Patient age: 50 years. Acquired with a Topcon TRC-NW400. Optic disc at the center of the field. Gender: F. Undilated pupil. IOP: 20 mmHg. 30° field of view.
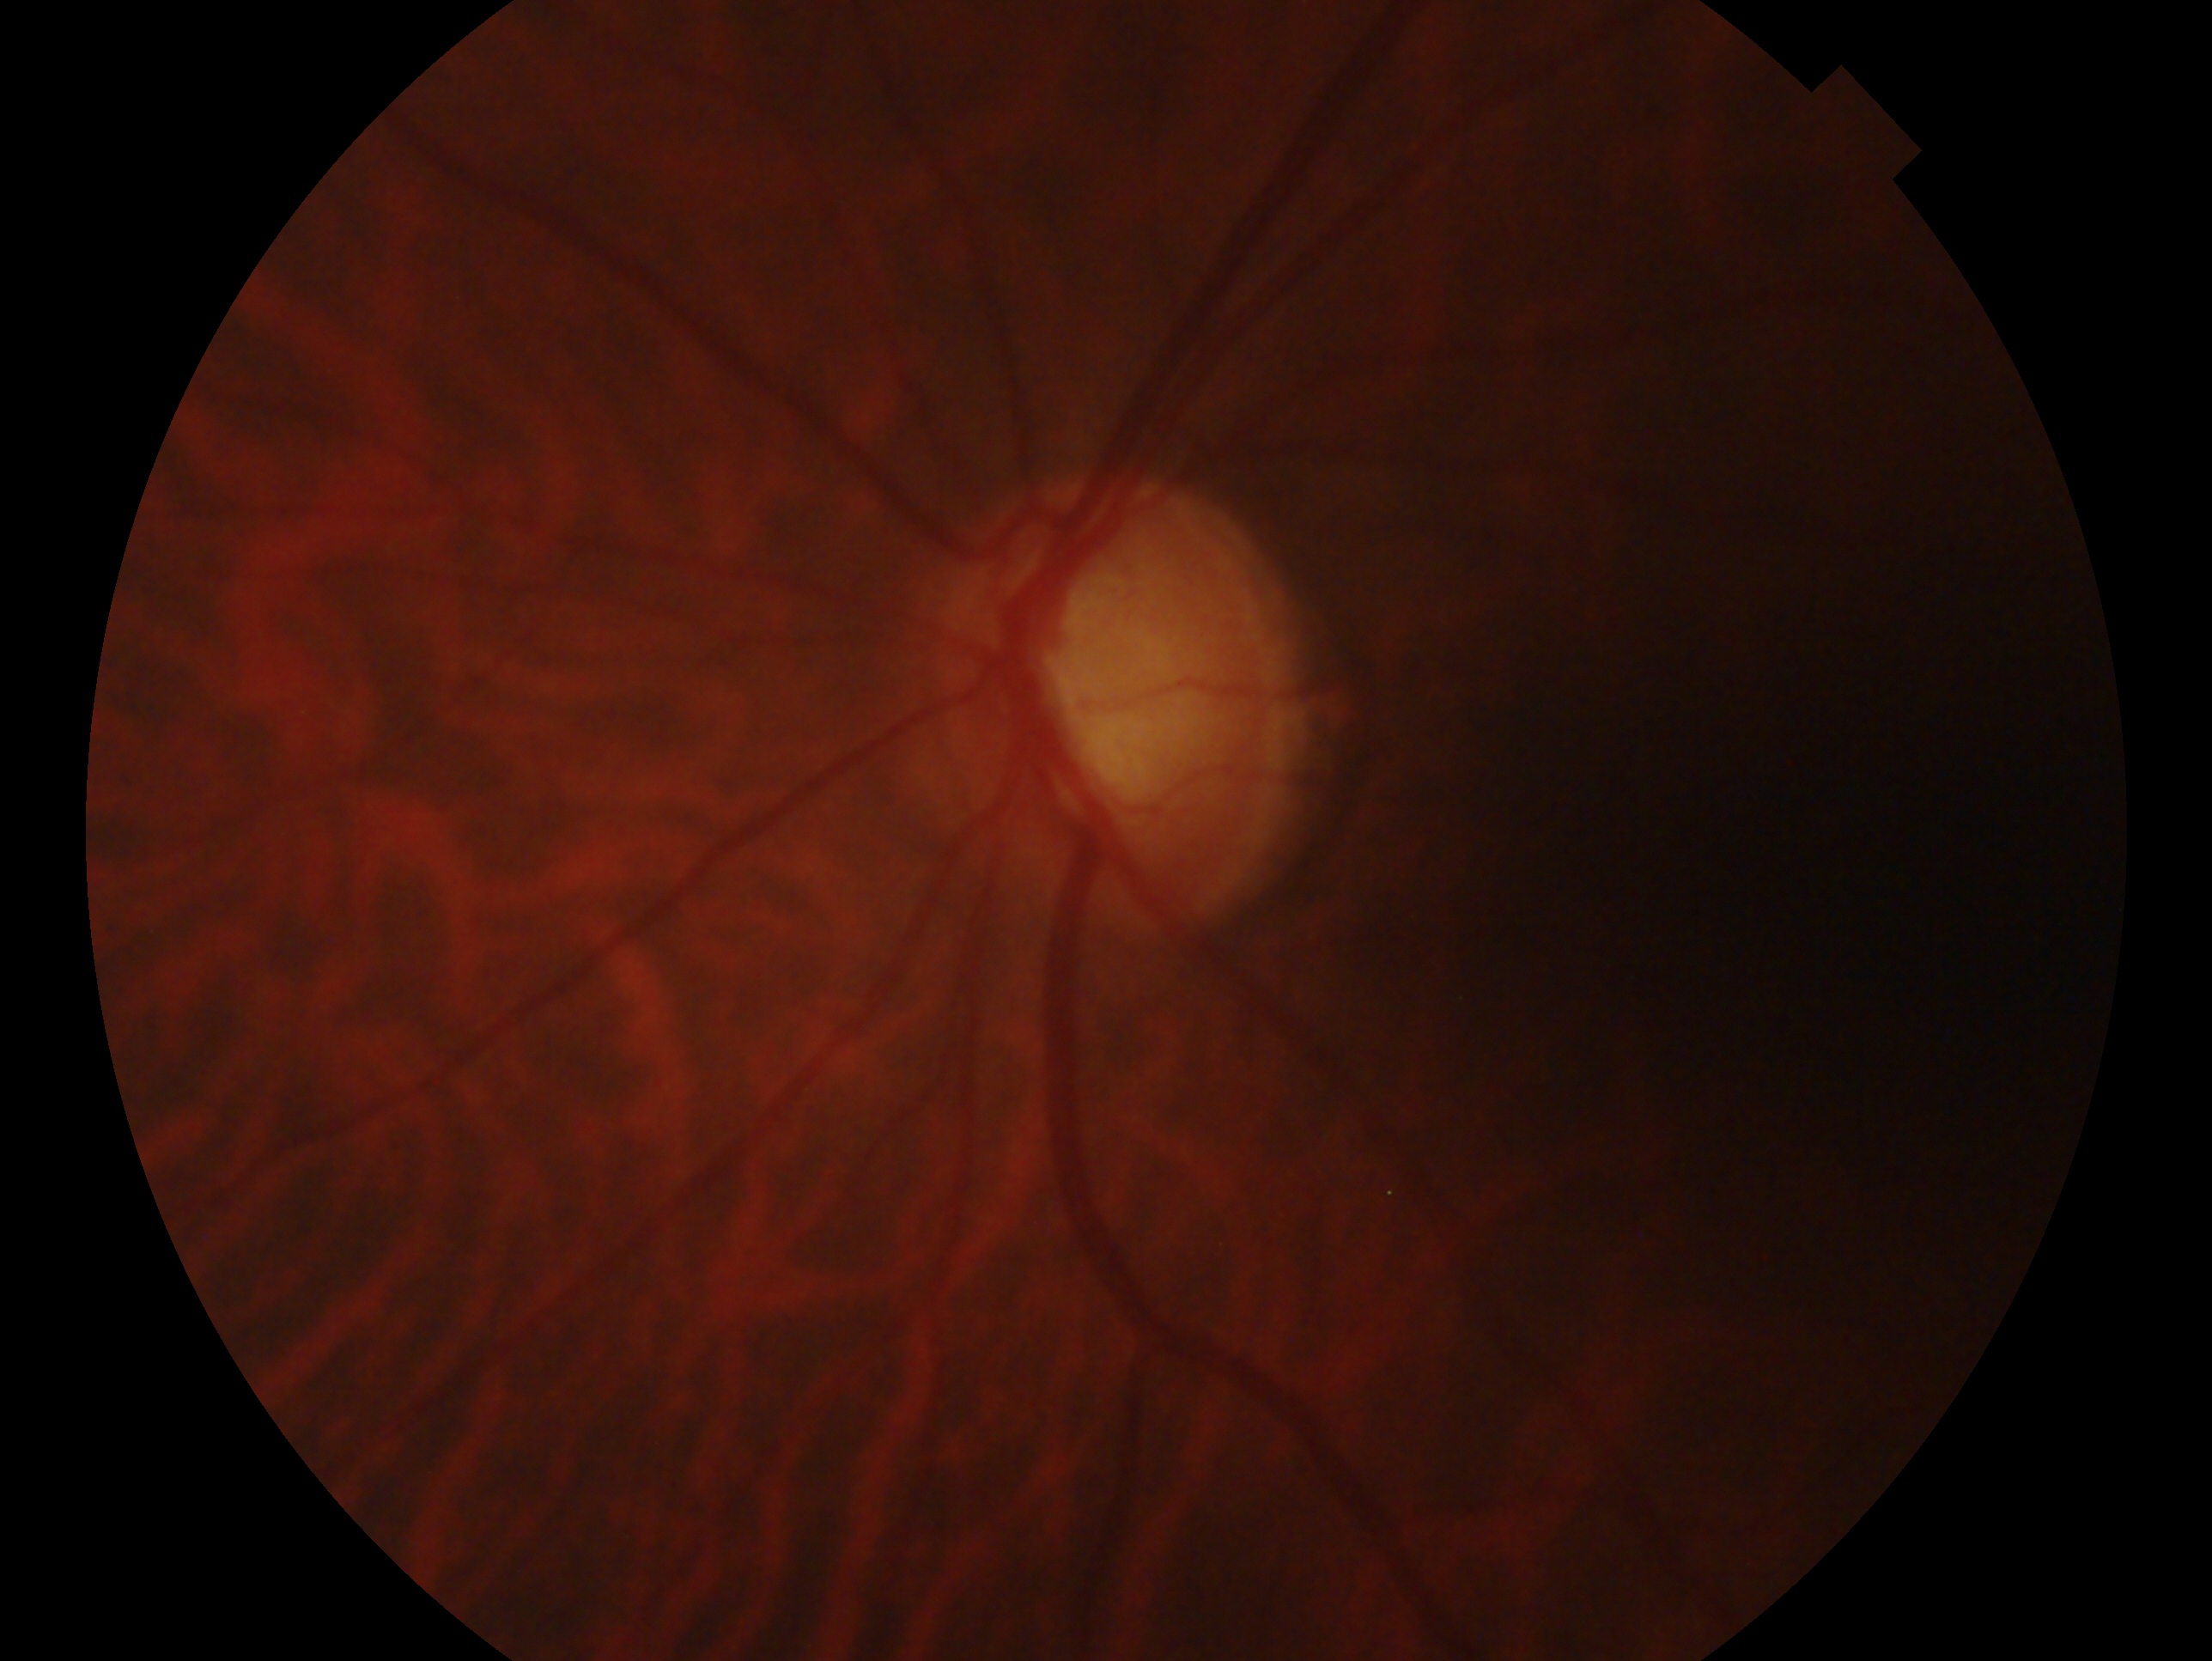 glaucoma status: consistent with glaucoma
laterality: left eye